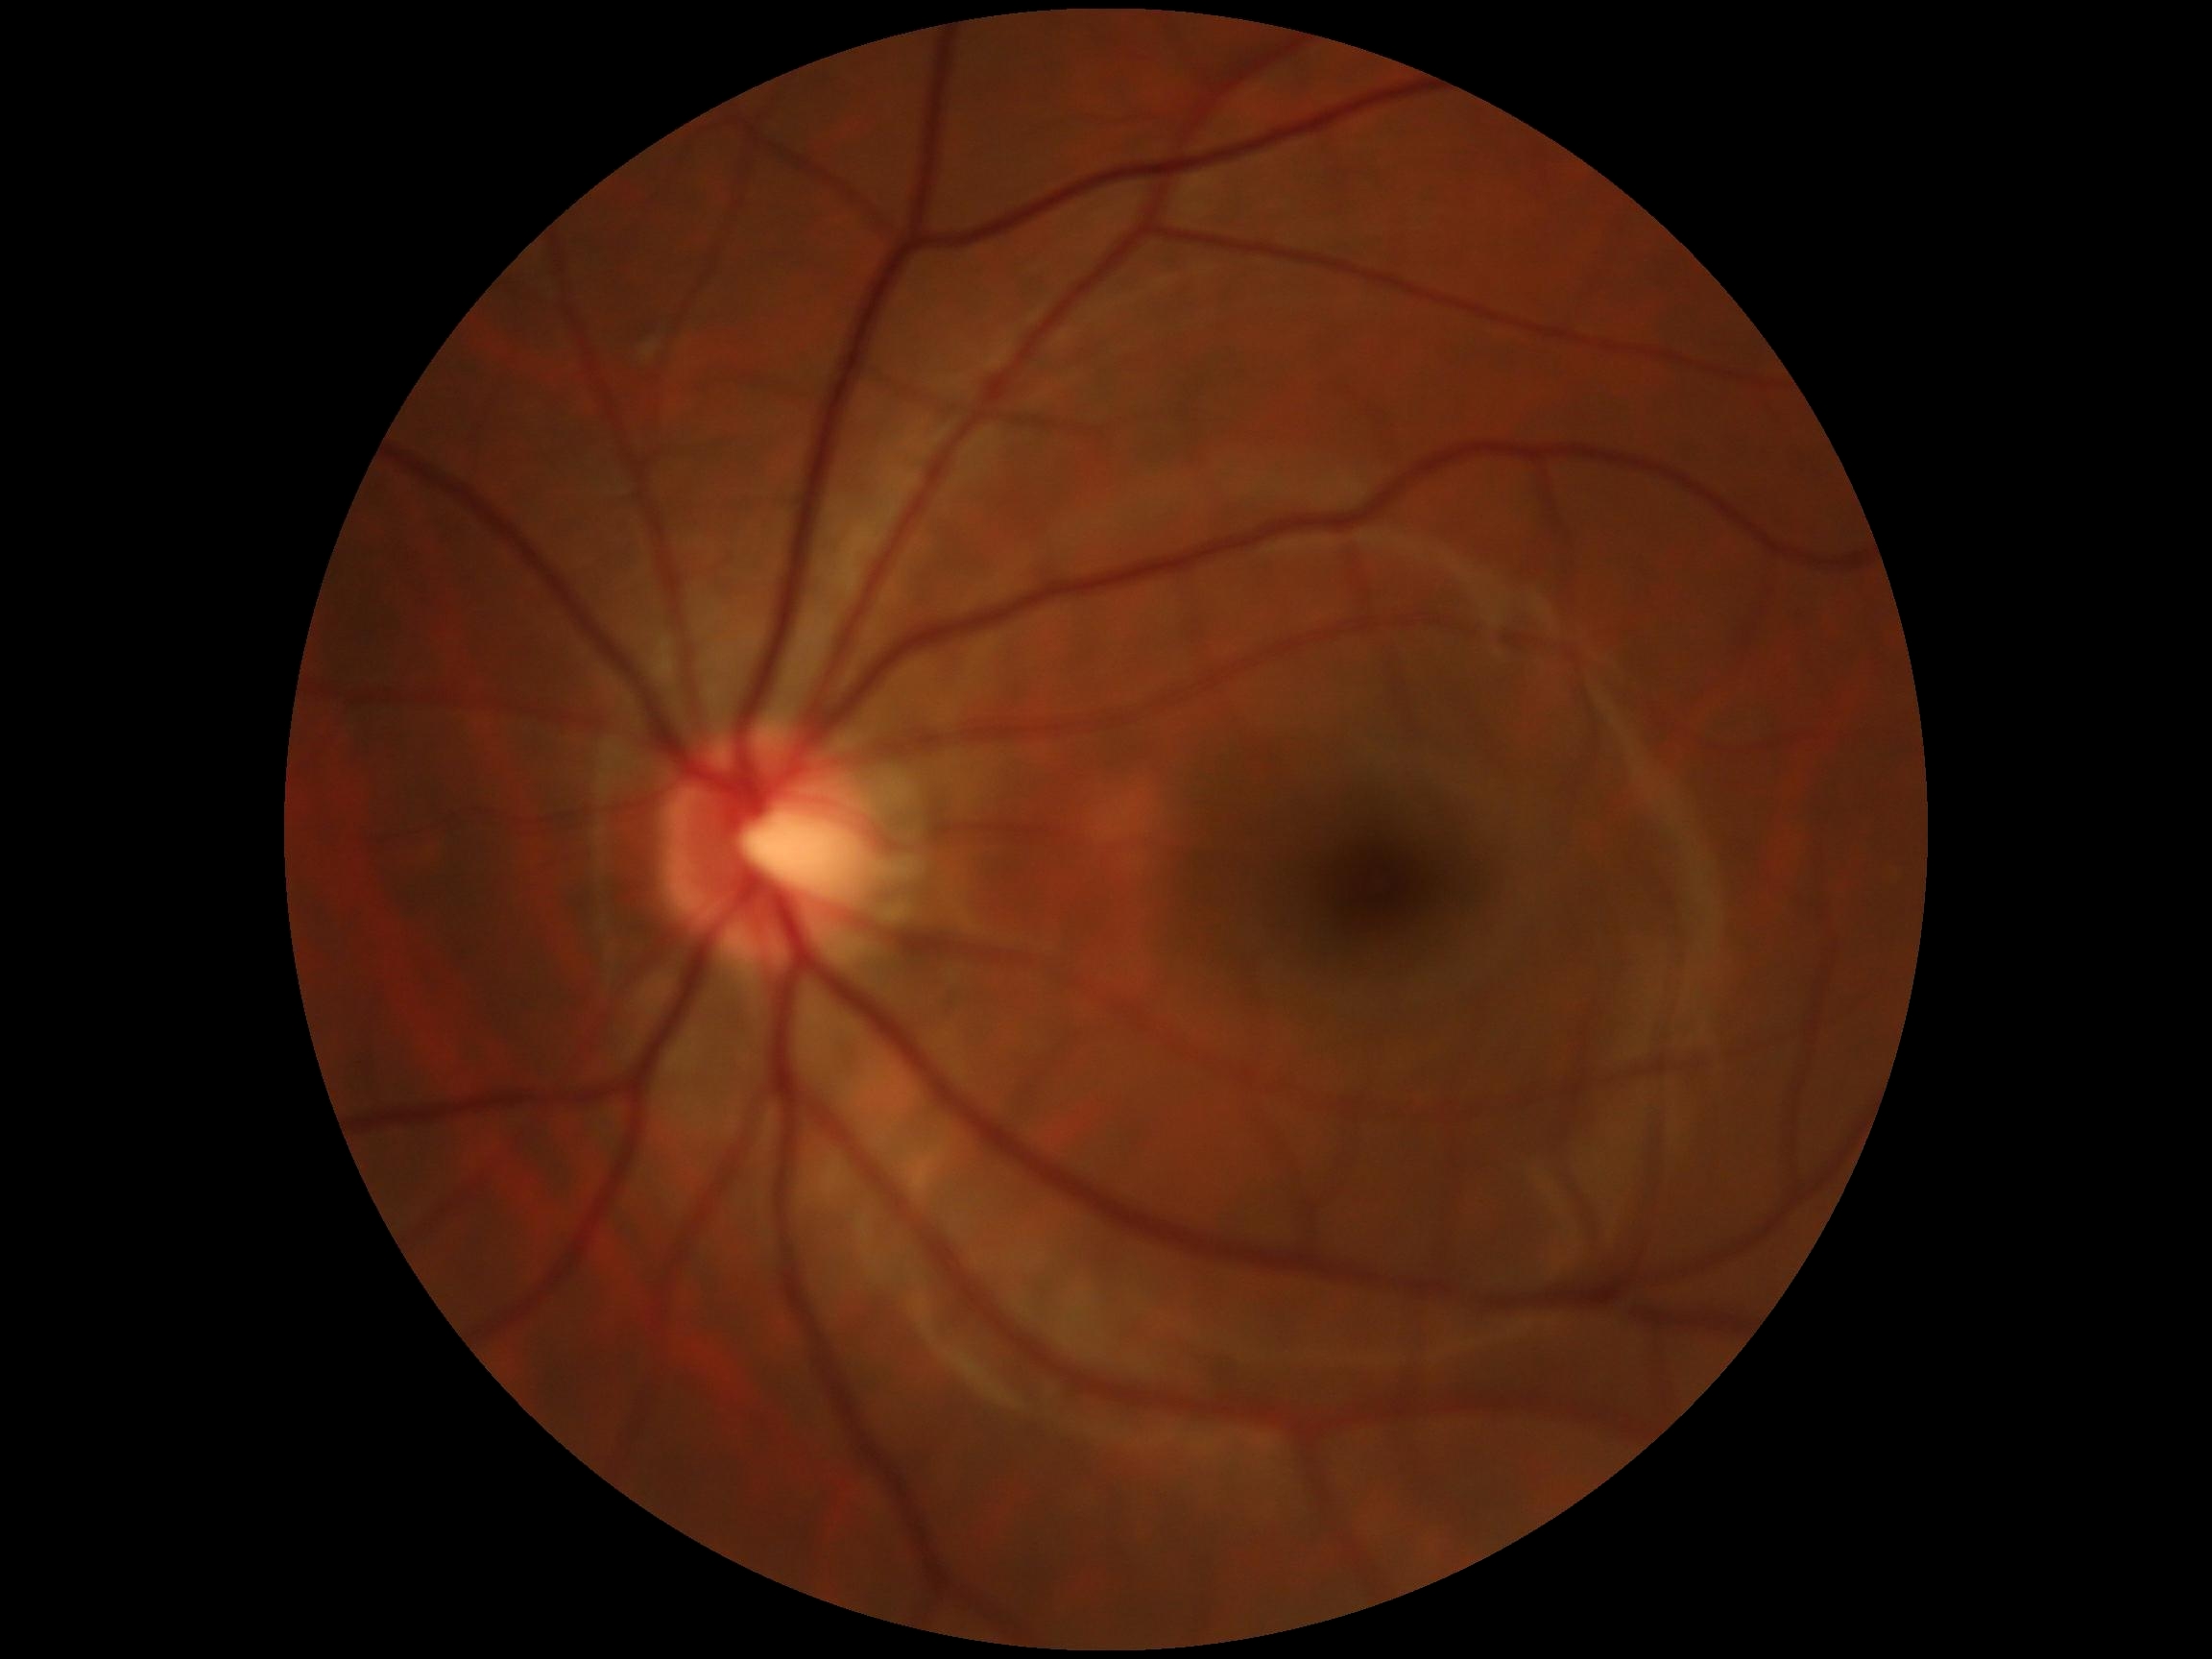

No diabetic retinal disease findings.
Diabetic retinopathy grade: no apparent retinopathy (0).